1240x1240 · wide-field fundus image from infant ROP screening: 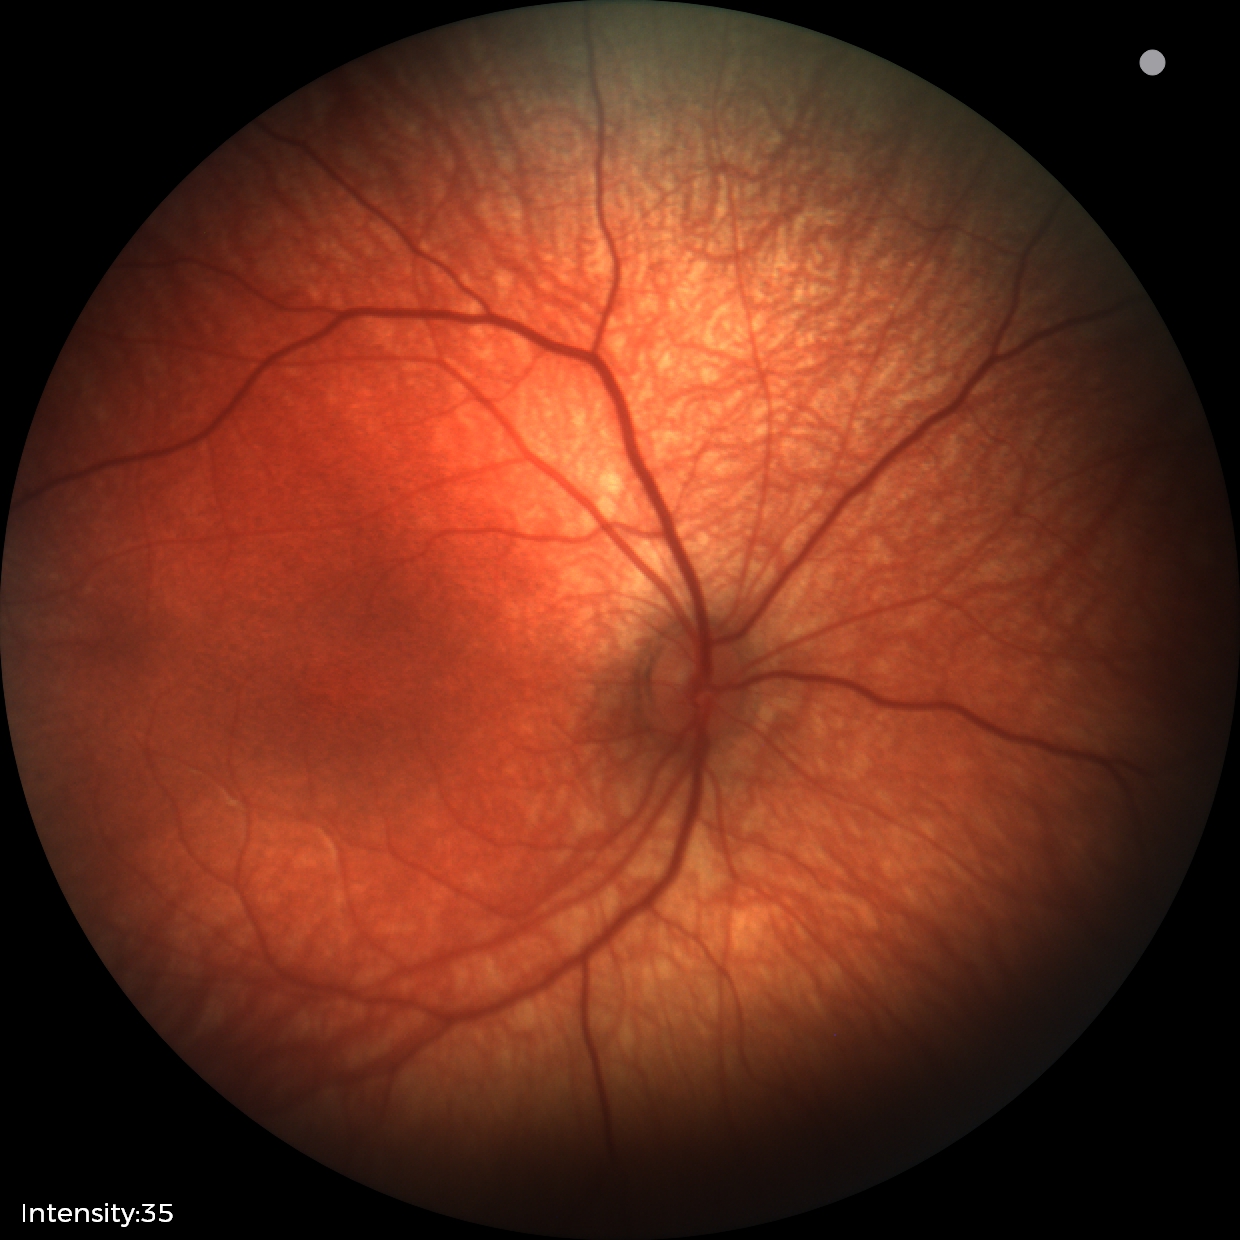

Examination with physiological retinal findings.